Wide-field fundus photograph from neonatal ROP screening · Natus RetCam Envision, 130° FOV
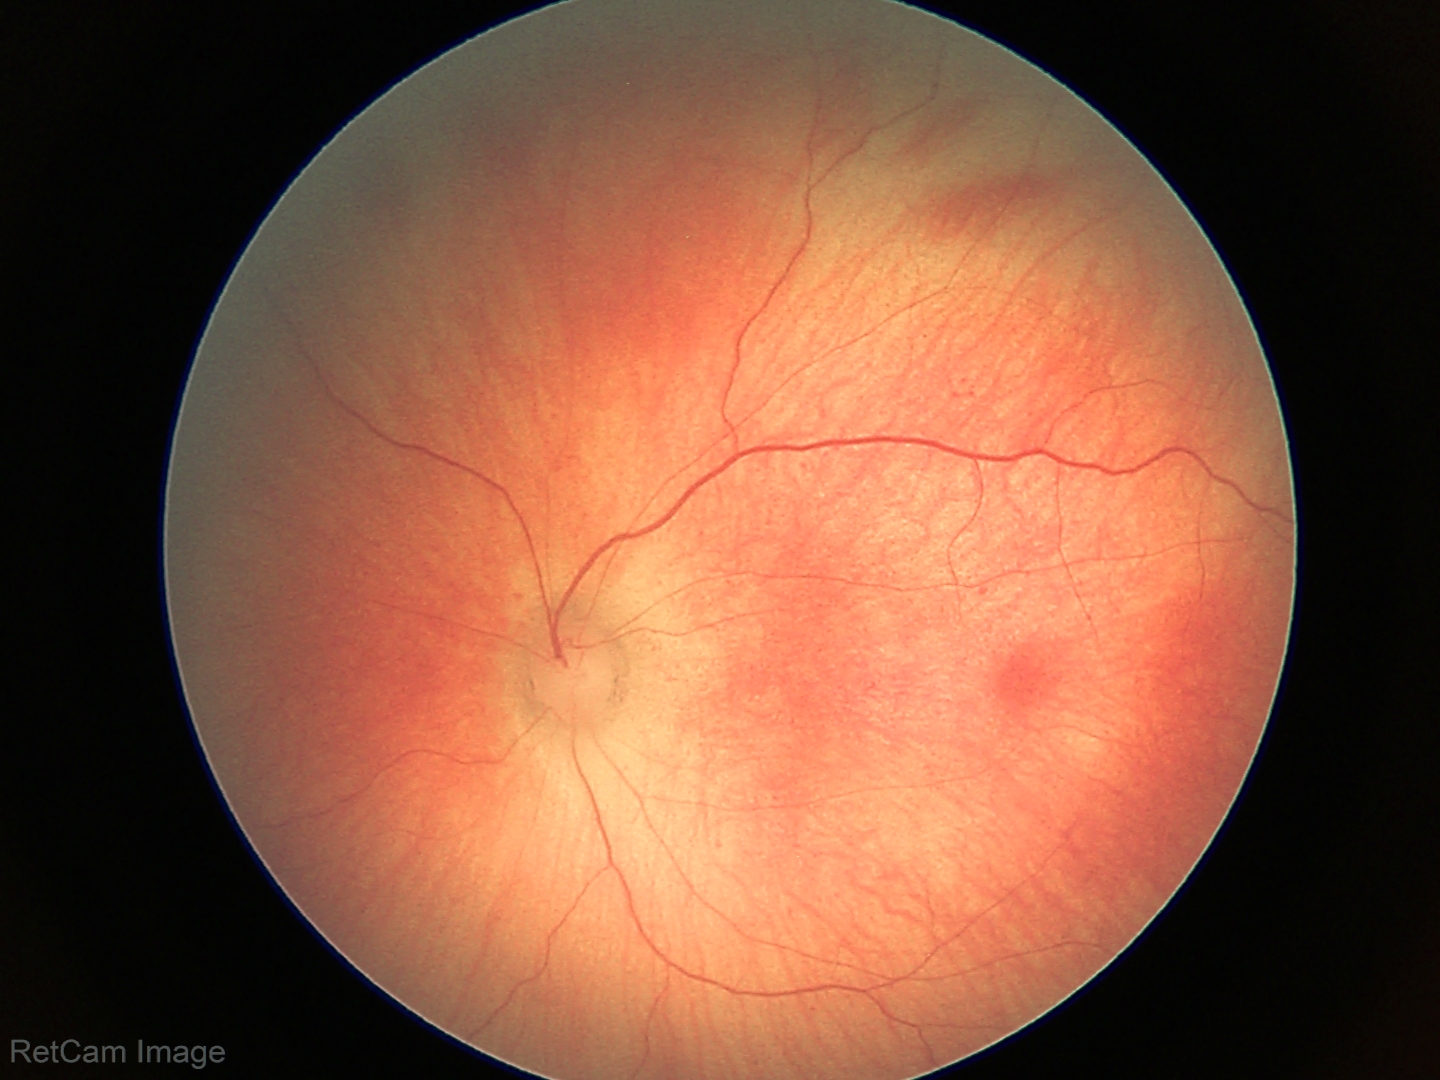

Series diagnosed as retinal hemorrhages.